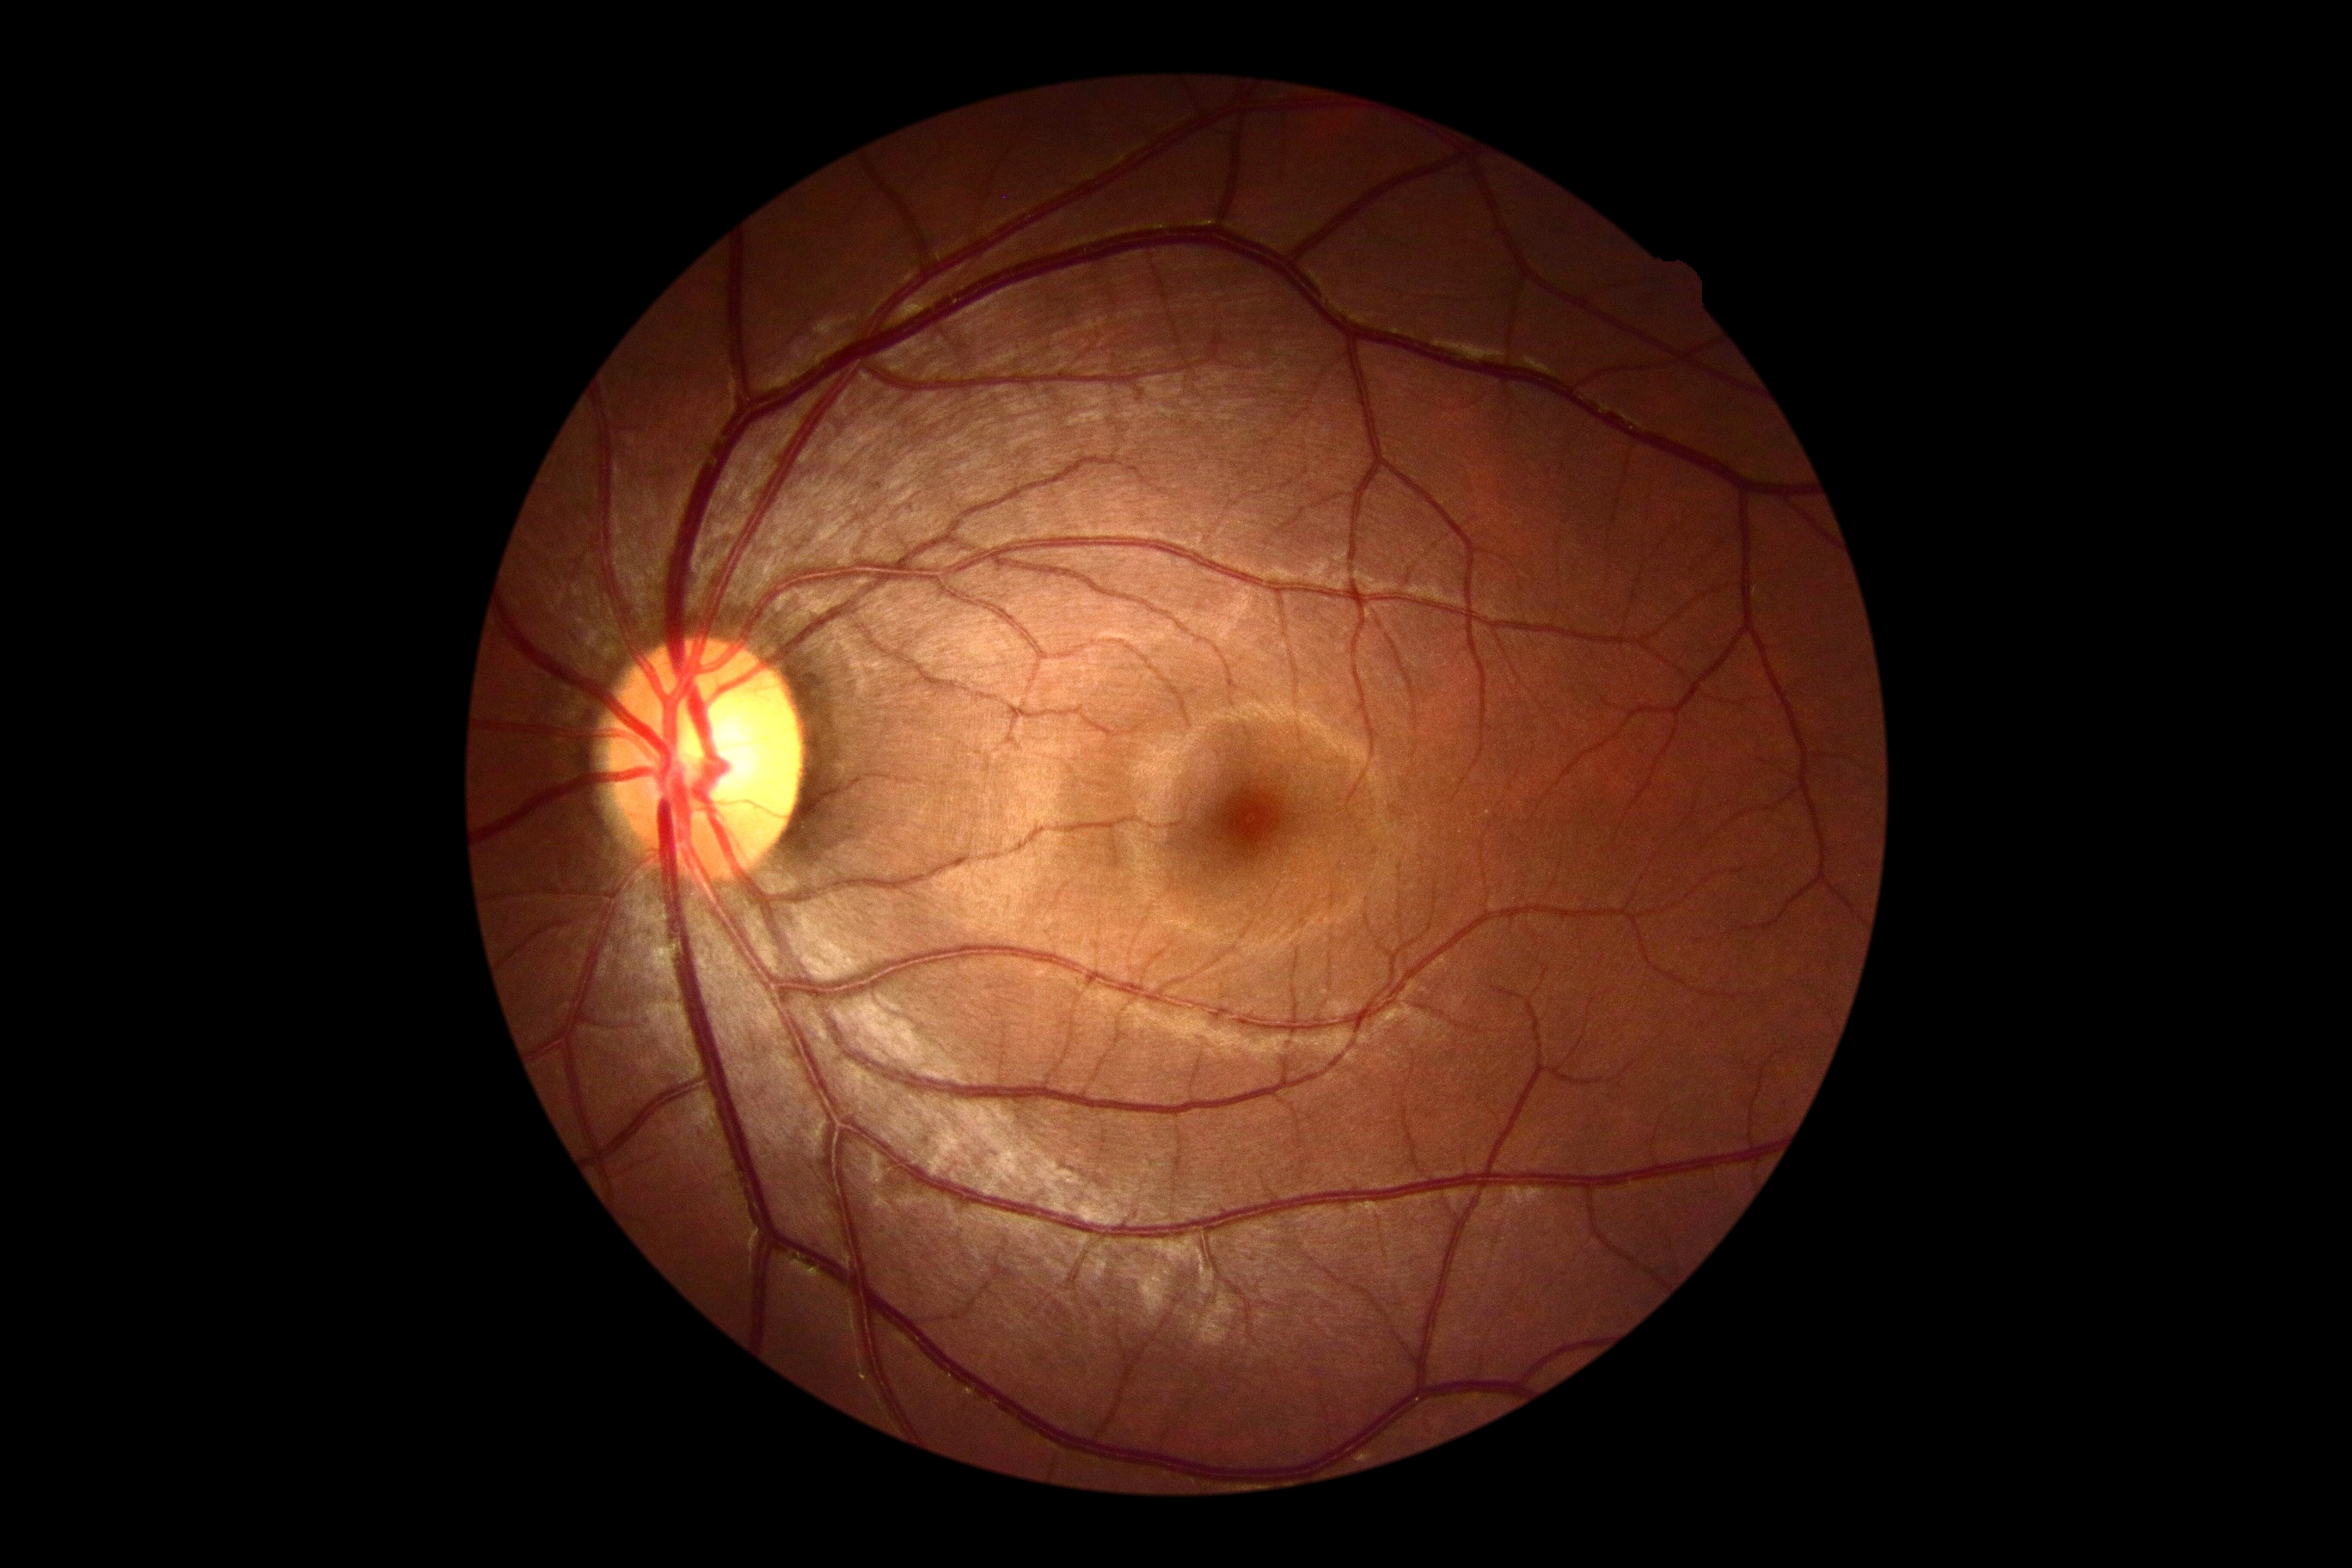 No diabetic retinal disease findings. DR stage is no apparent diabetic retinopathy (grade 0).